45-degree field of view, NIDEK AFC-230 fundus camera — 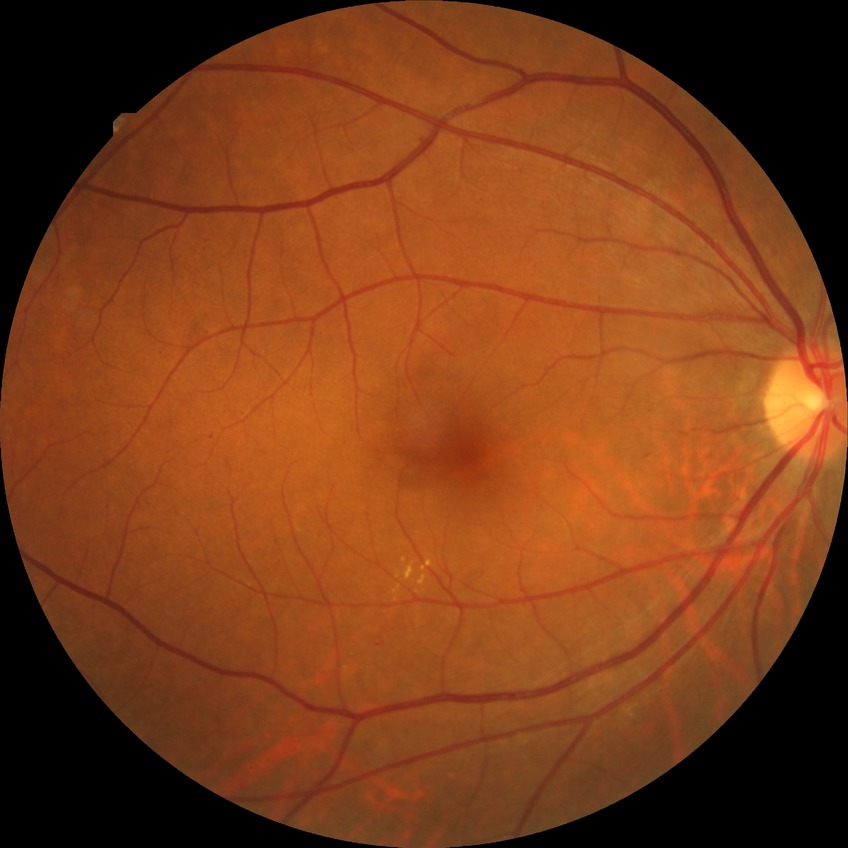 Findings:
* DR severity — SDR